Wide-field fundus photograph from neonatal ROP screening; Clarity RetCam 3, 130° FOV — 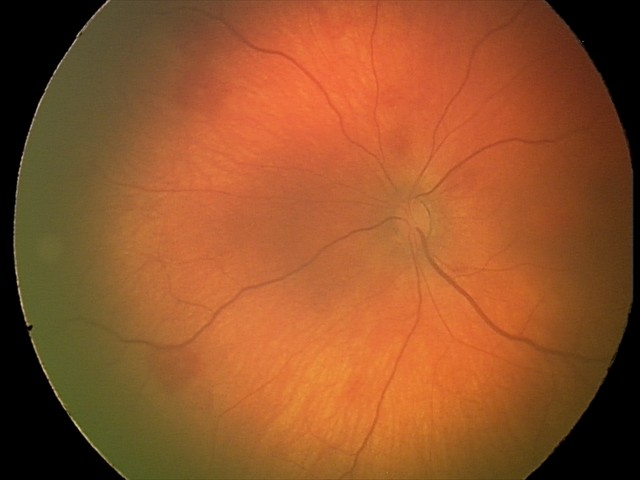 Screening: retinal hemorrhages.